FOV: 45 degrees. 2352x1568.
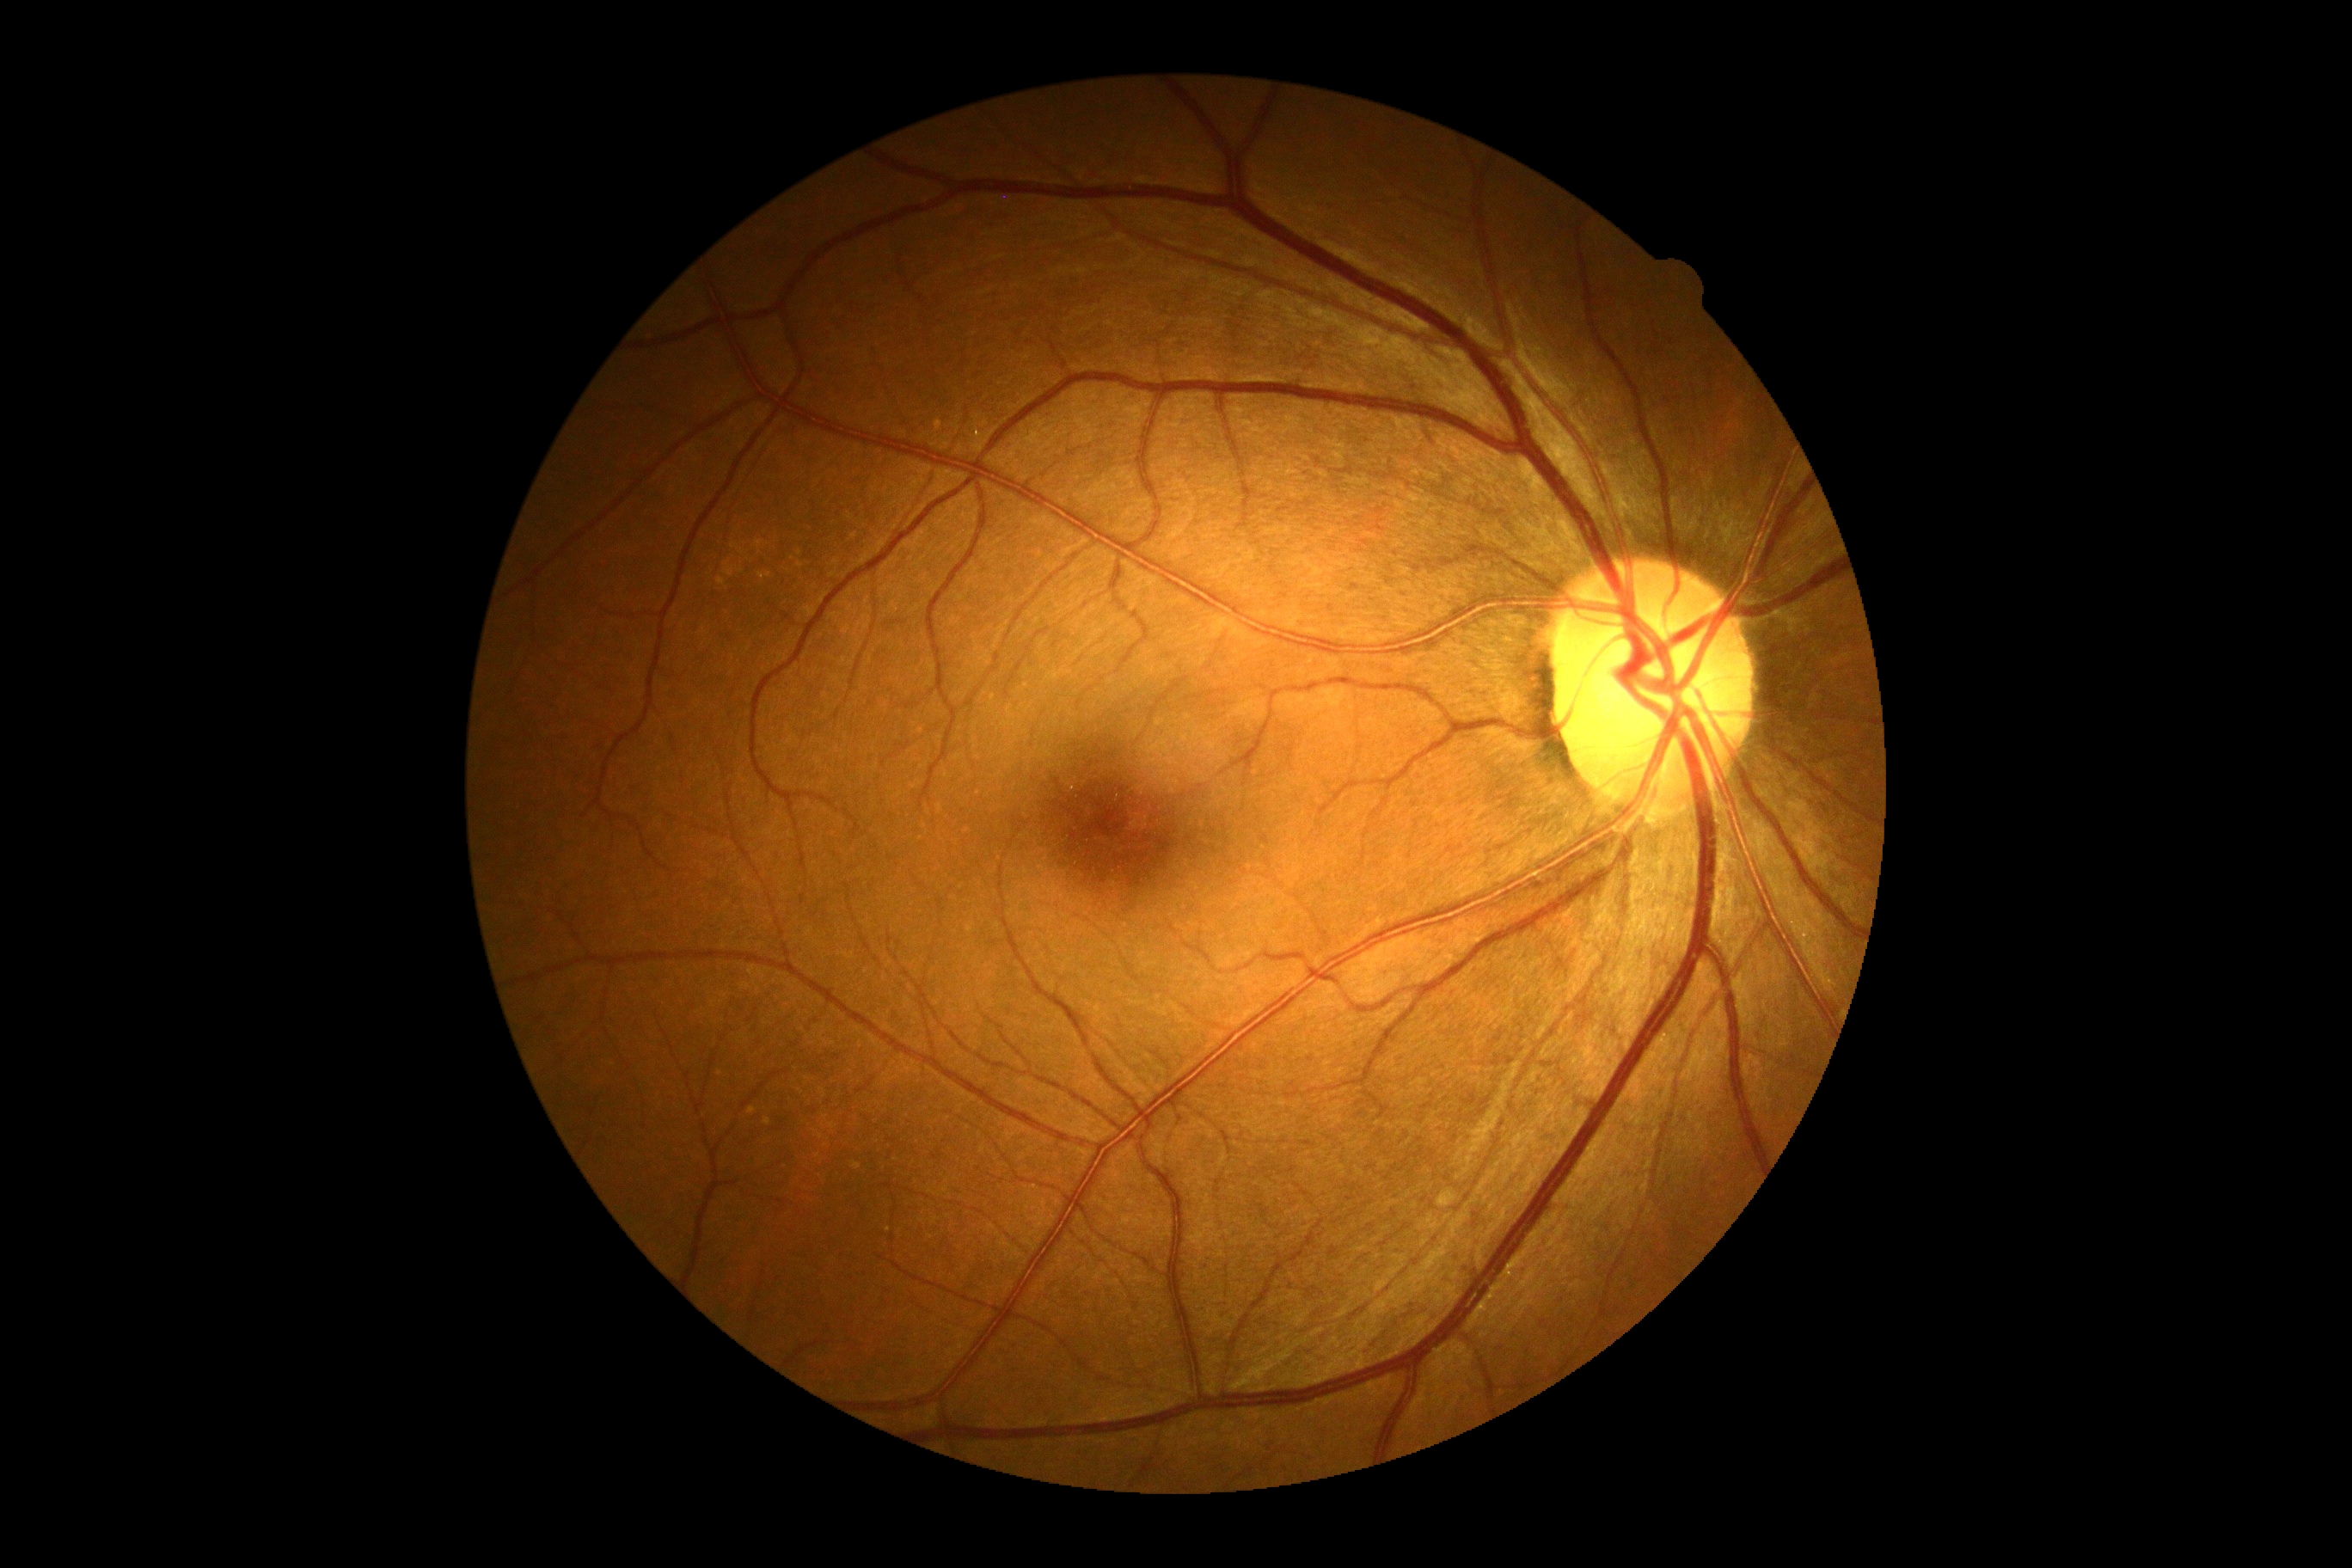
No apparent diabetic retinopathy. DR stage is 0/4.